Topcon TRC-NW8, 50° field of view
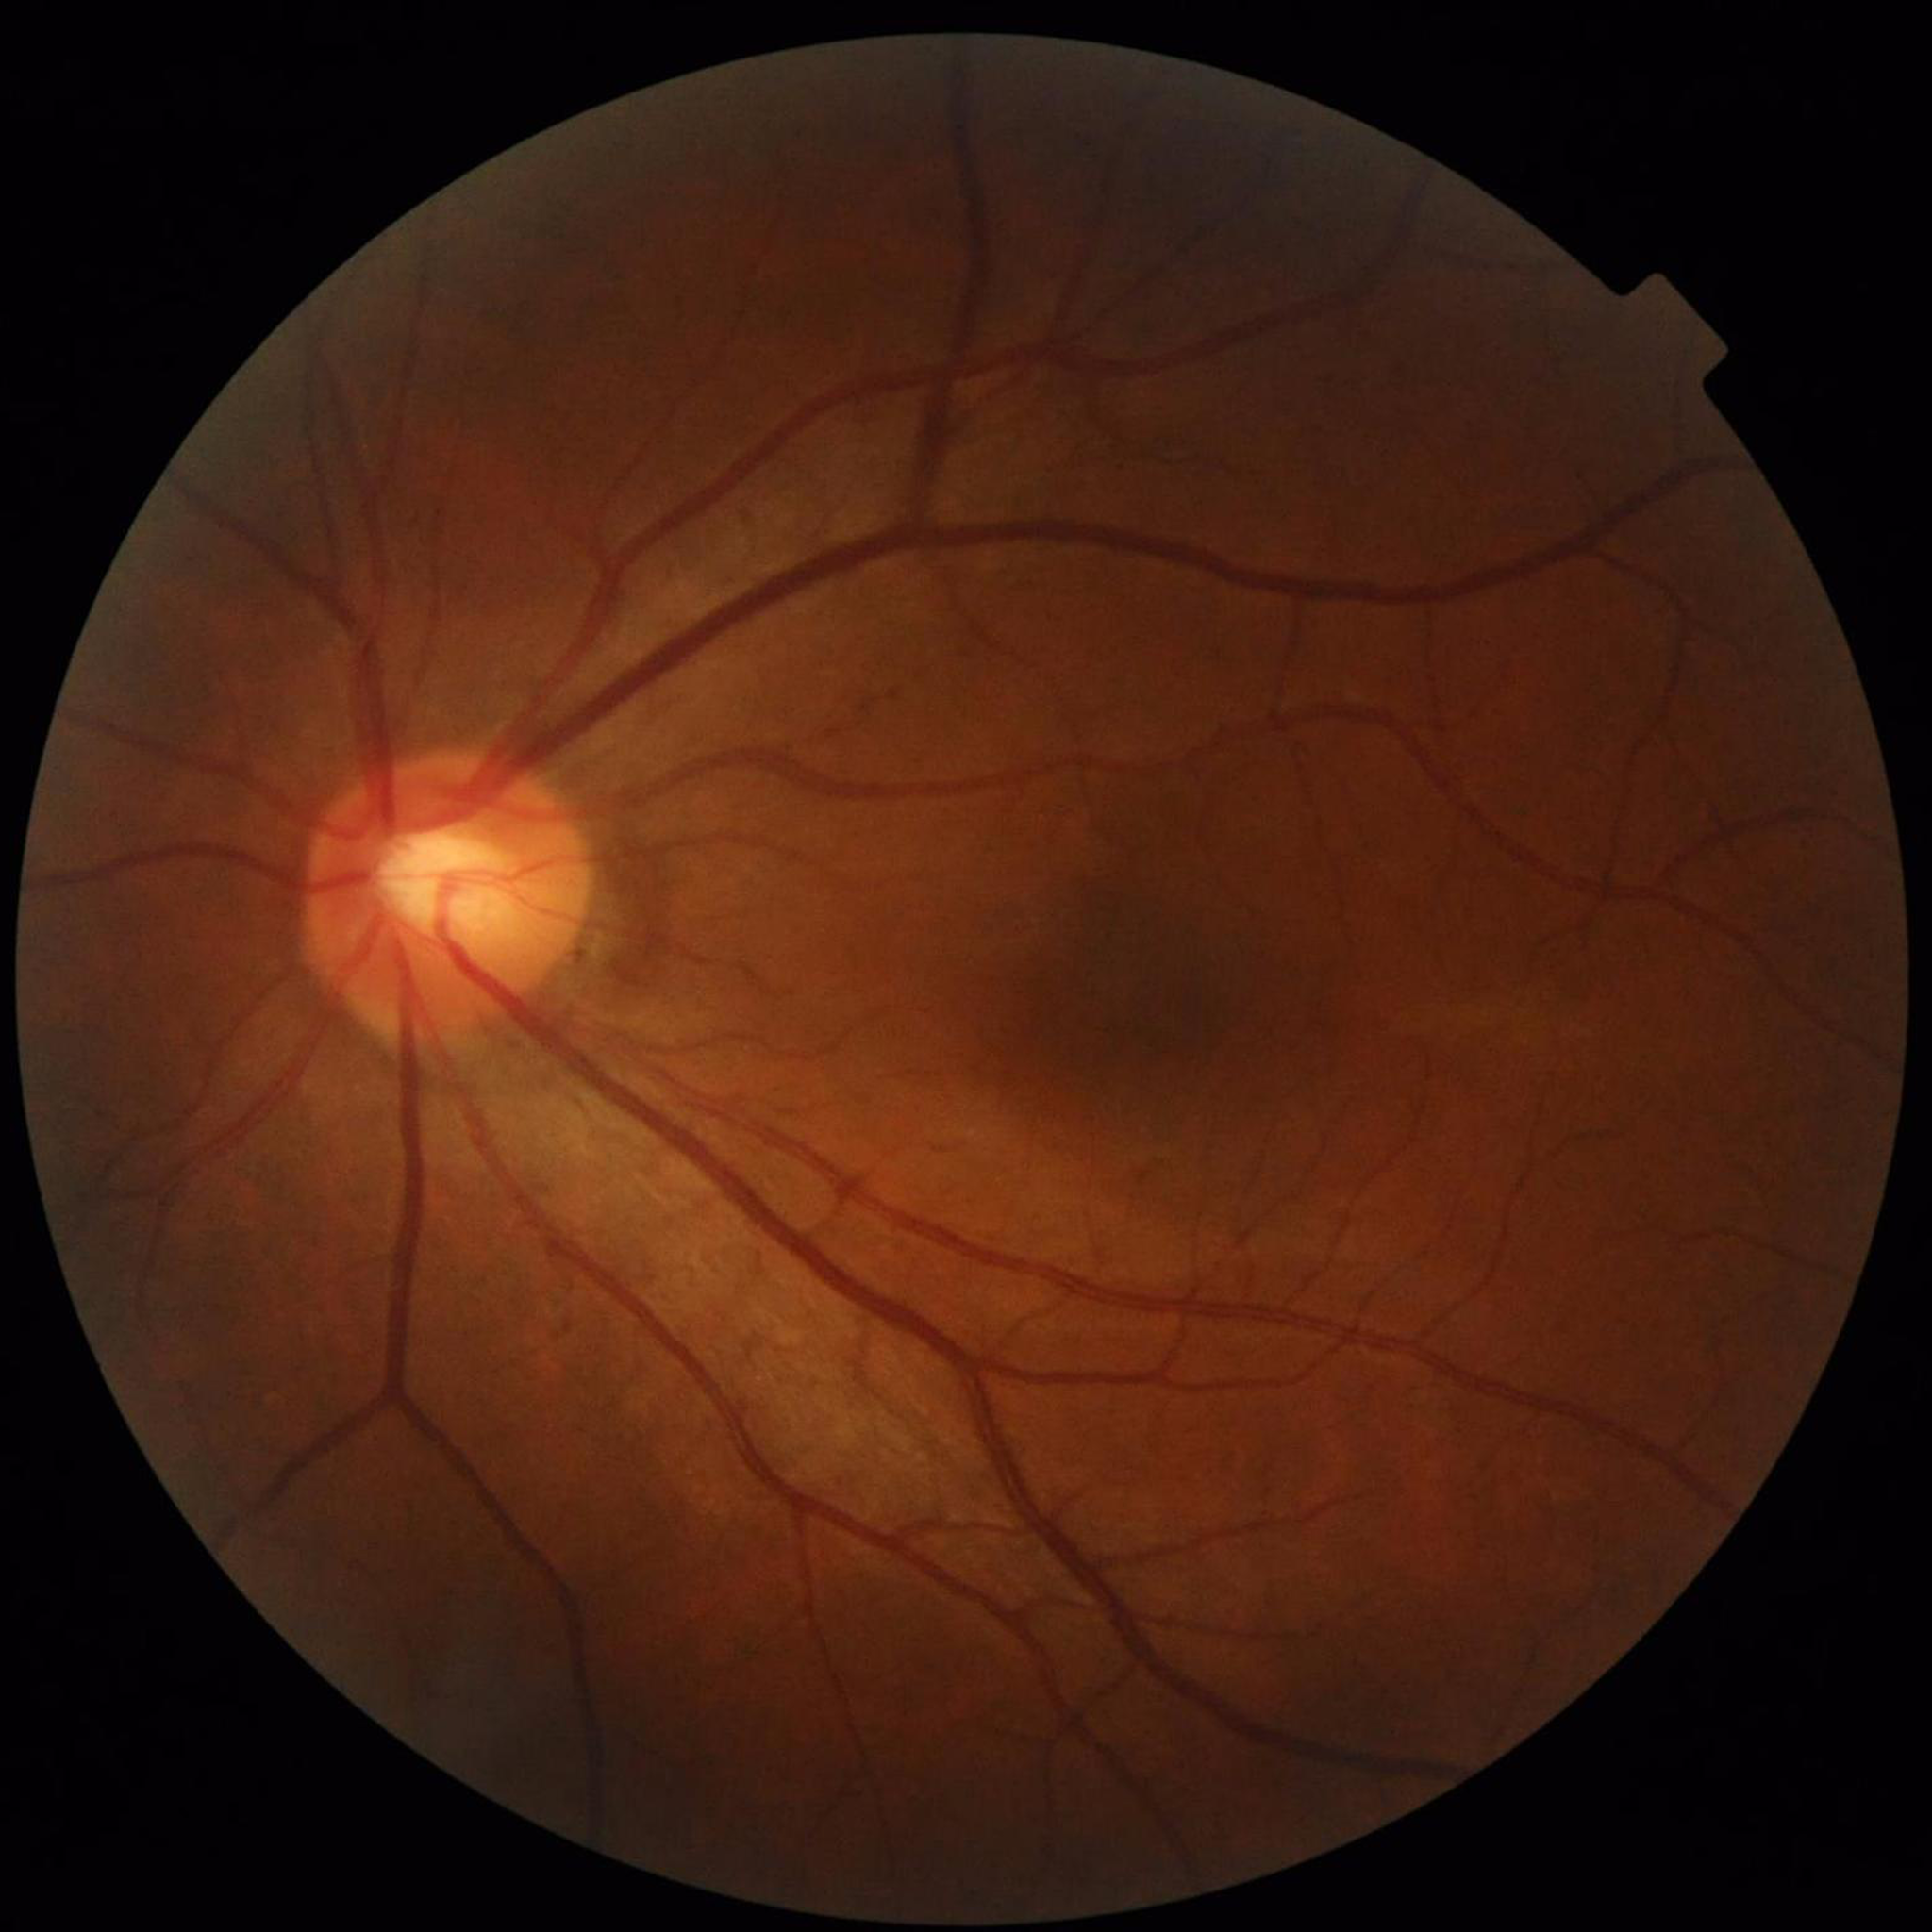
Condition = glaucoma.